Wide-field fundus photograph from neonatal ROP screening:
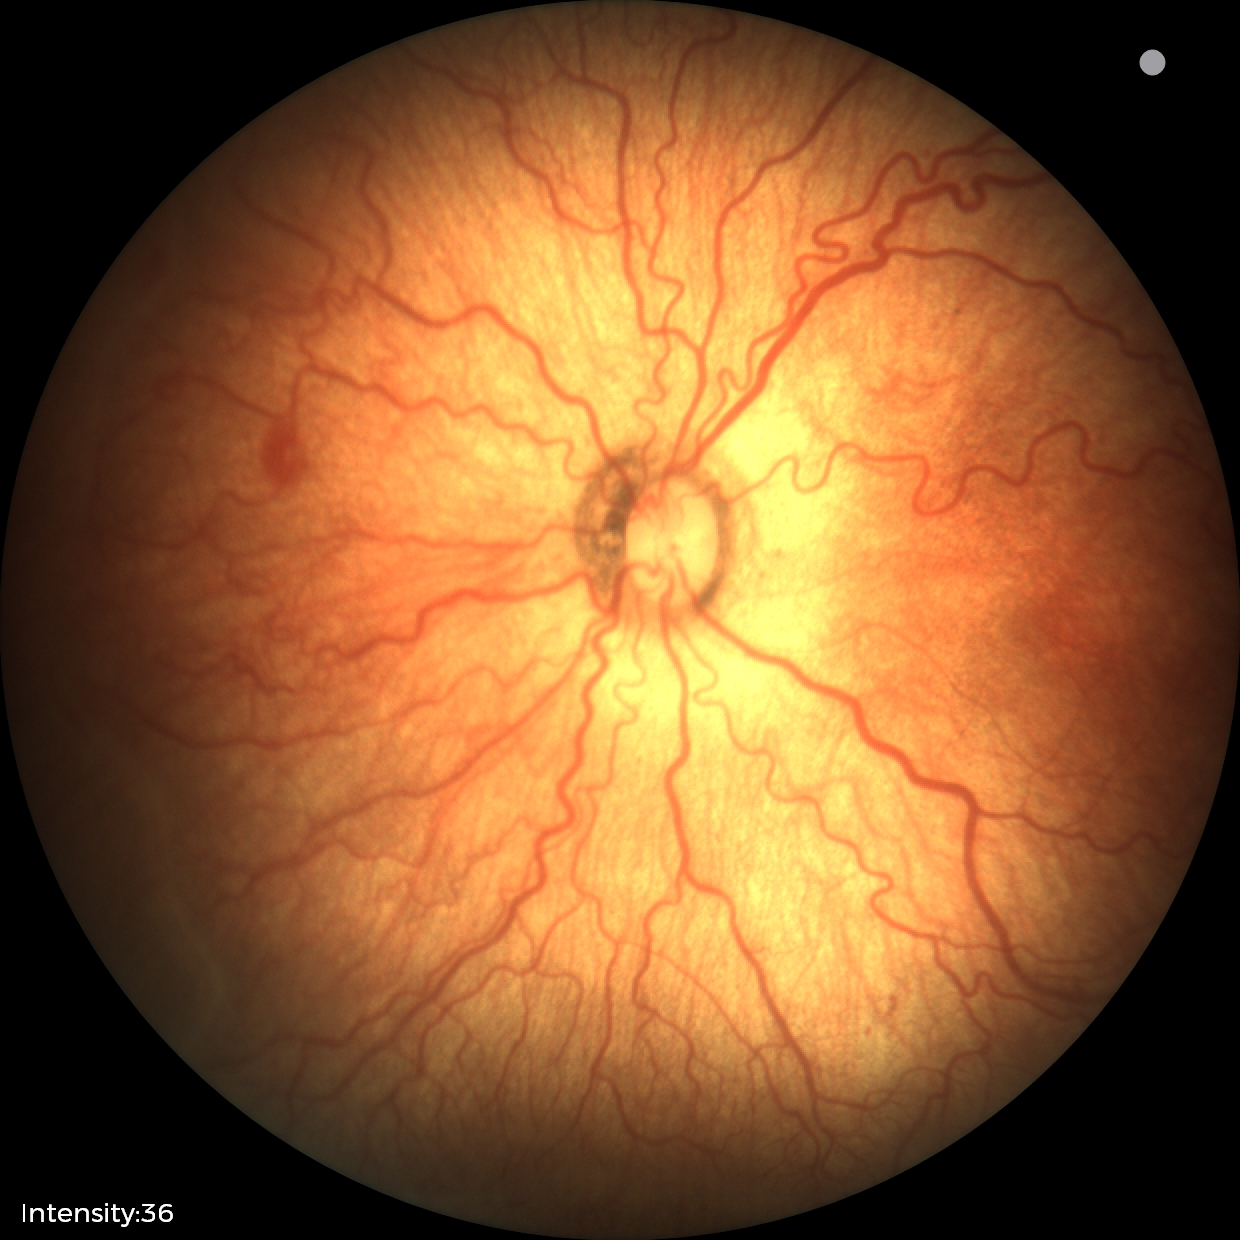
Examination diagnosed as retinopathy of prematurity (ROP) stage 2.